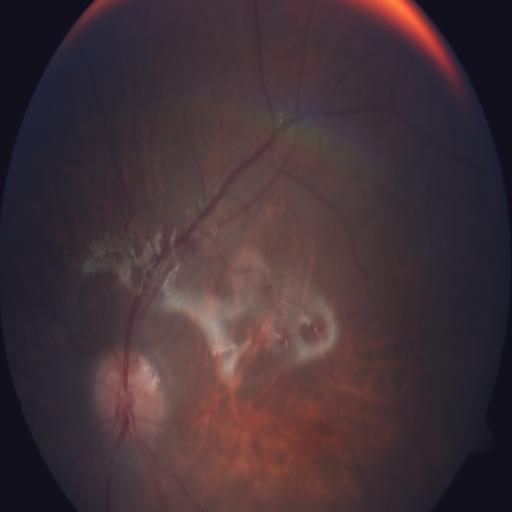

The image shows retinal traction (RT).